FOV: 45 degrees, CFP: 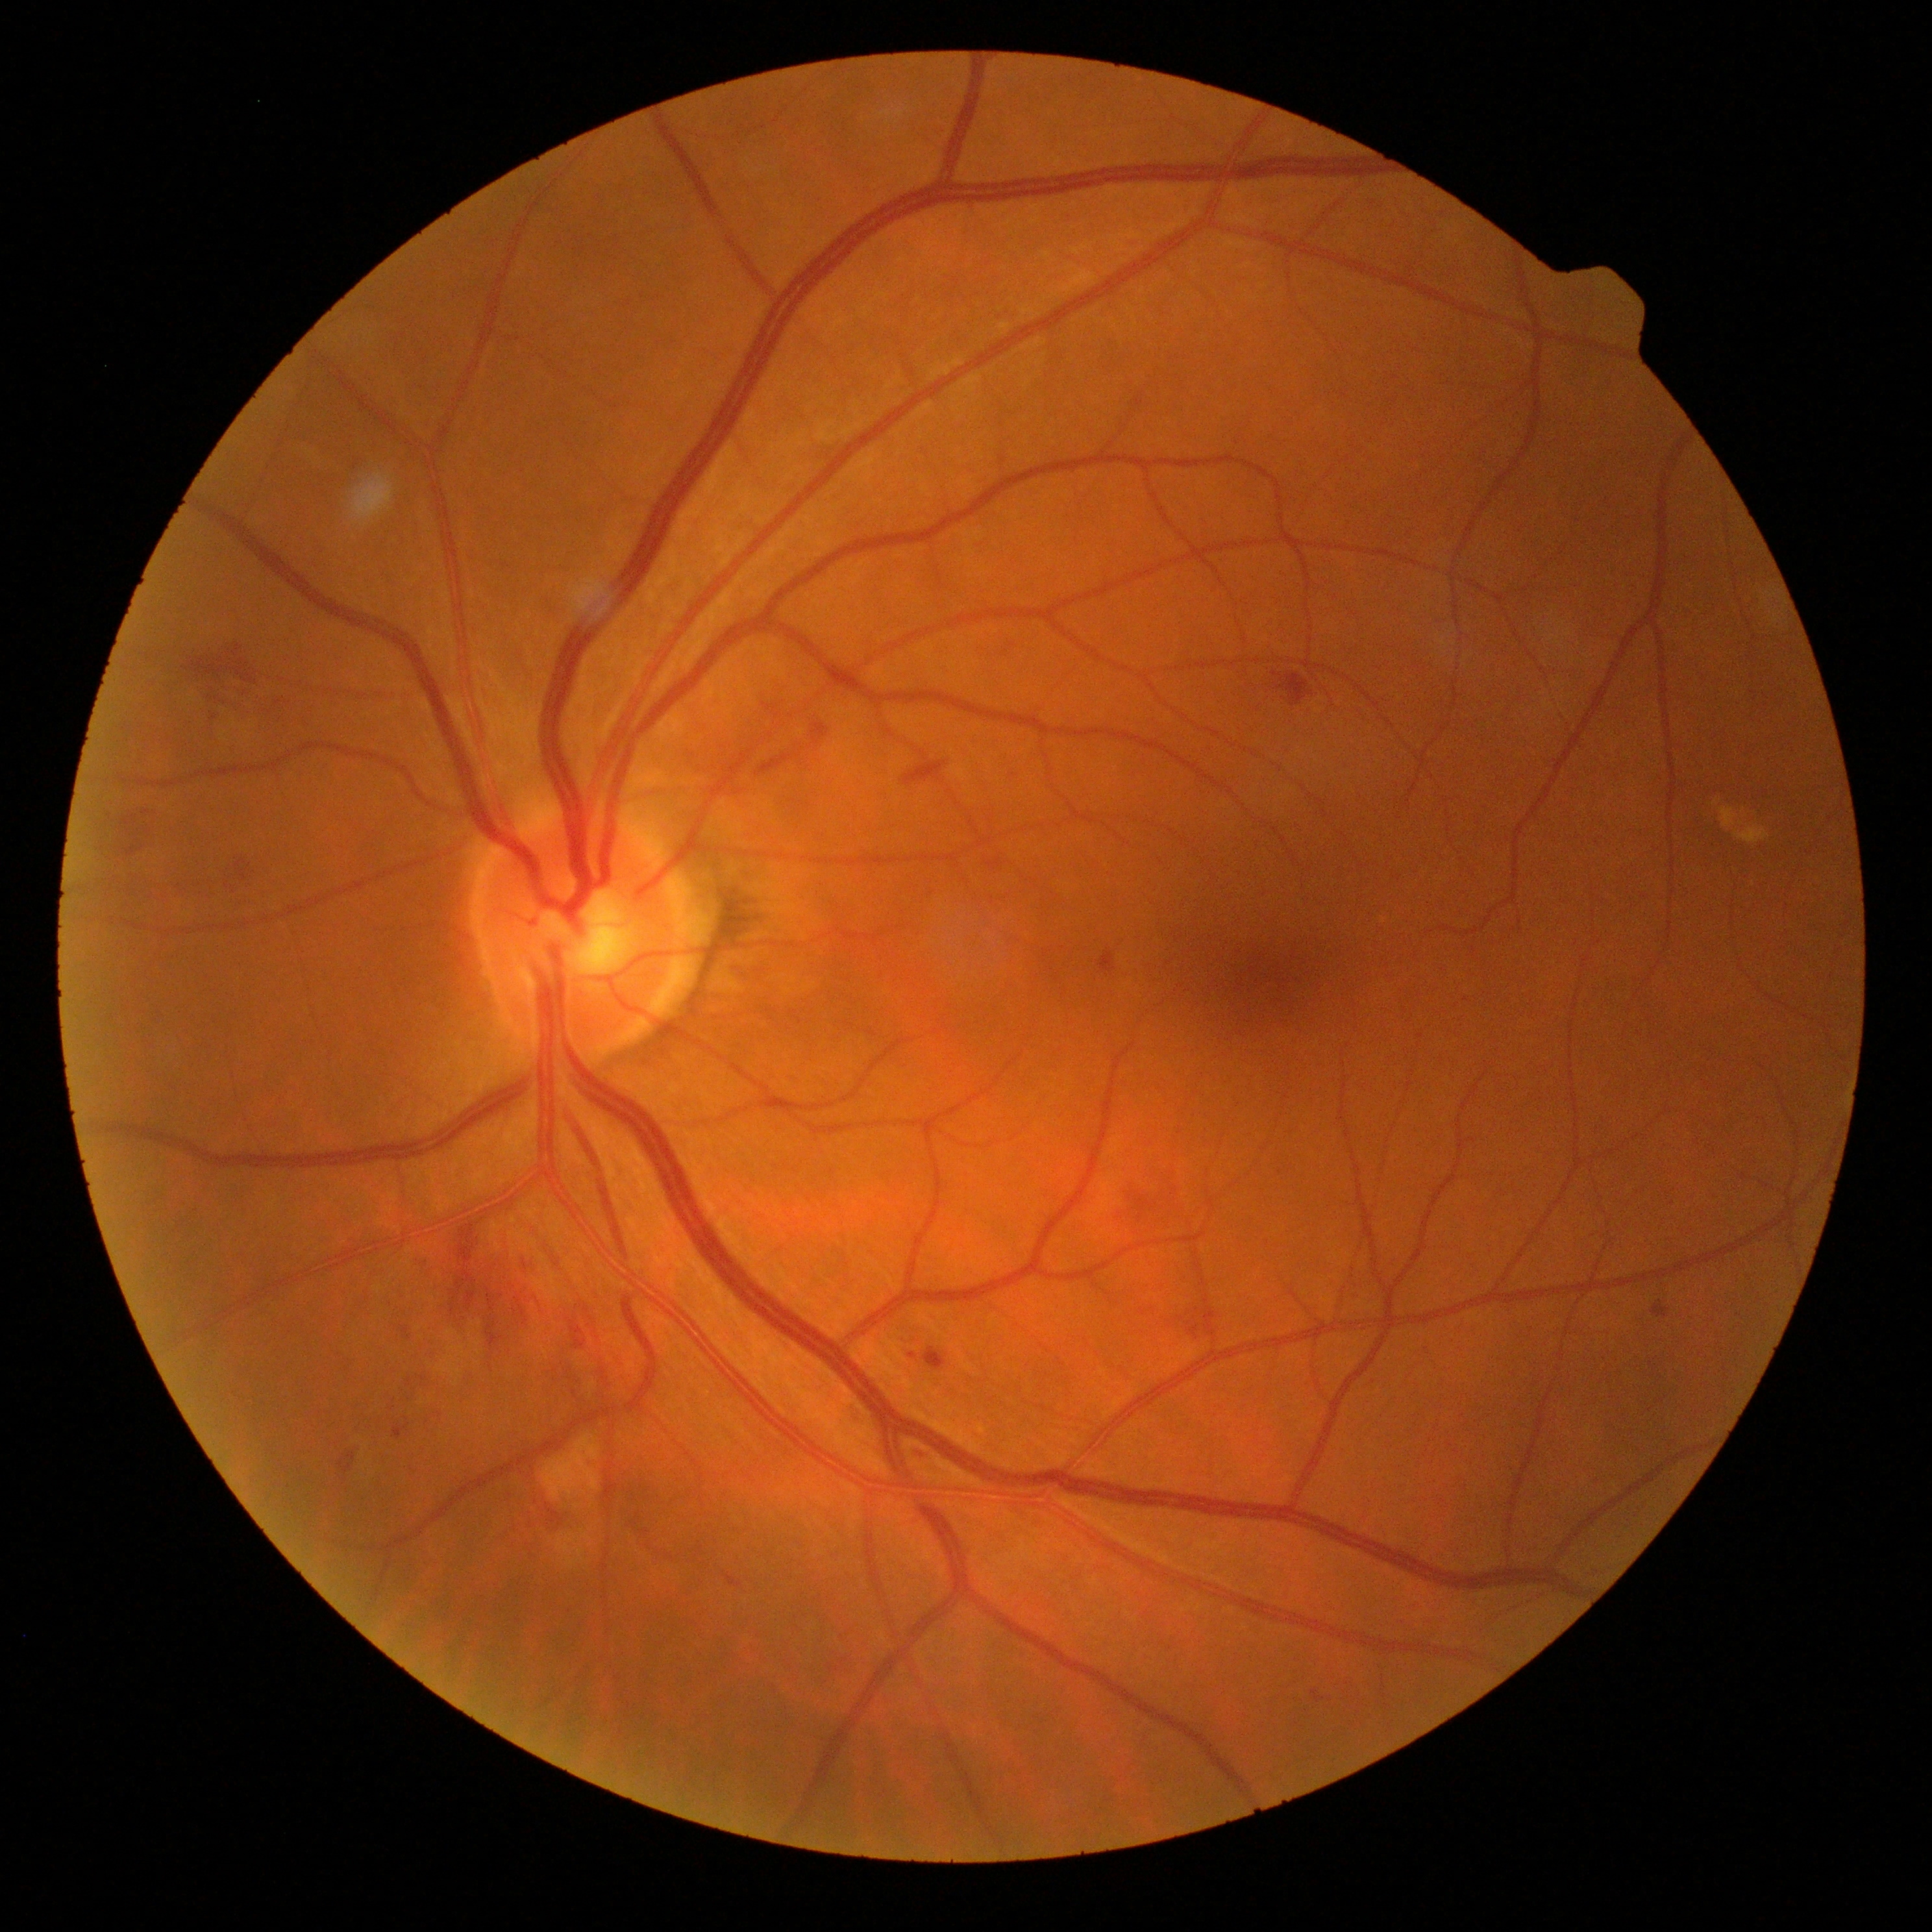 DR grade is moderate NPDR (2).